Non-mydriatic acquisition; CFP — 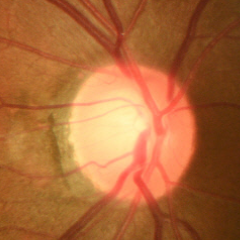
There is evidence of early glaucomatous optic neuropathy.